1536 x 1152 pixels: 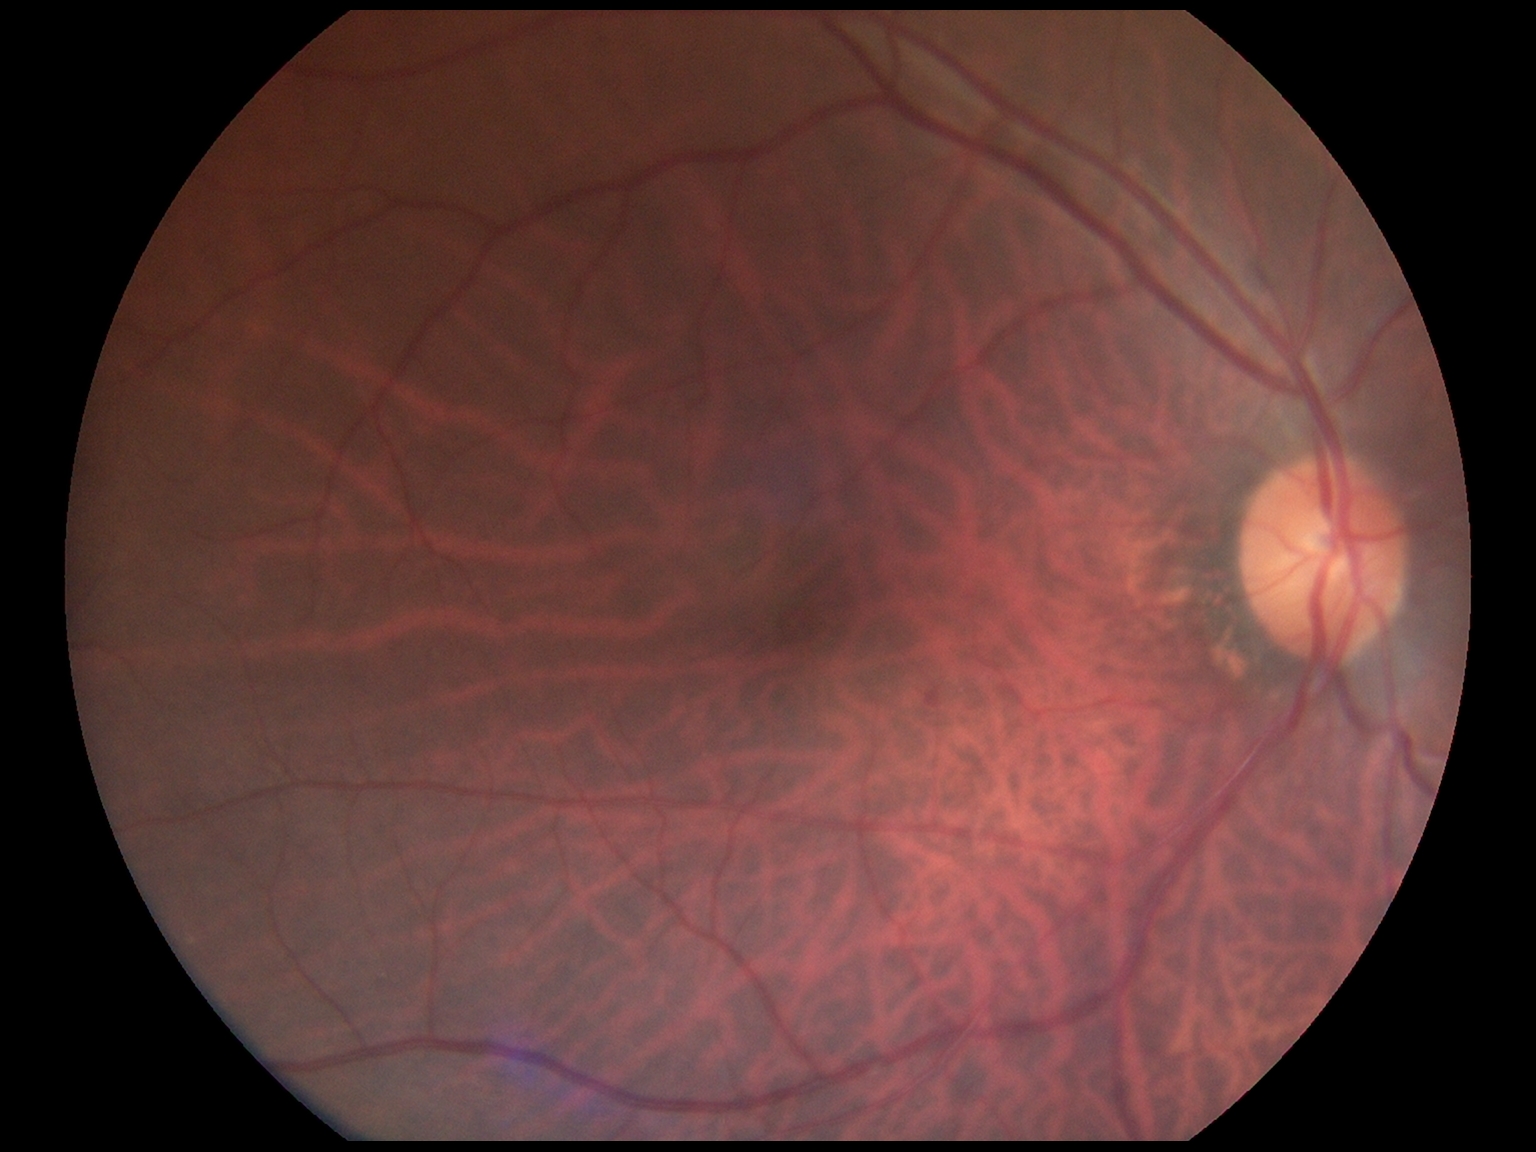

Diabetic retinopathy (DR) is grade 1 (mild NPDR).